2089x1764px:
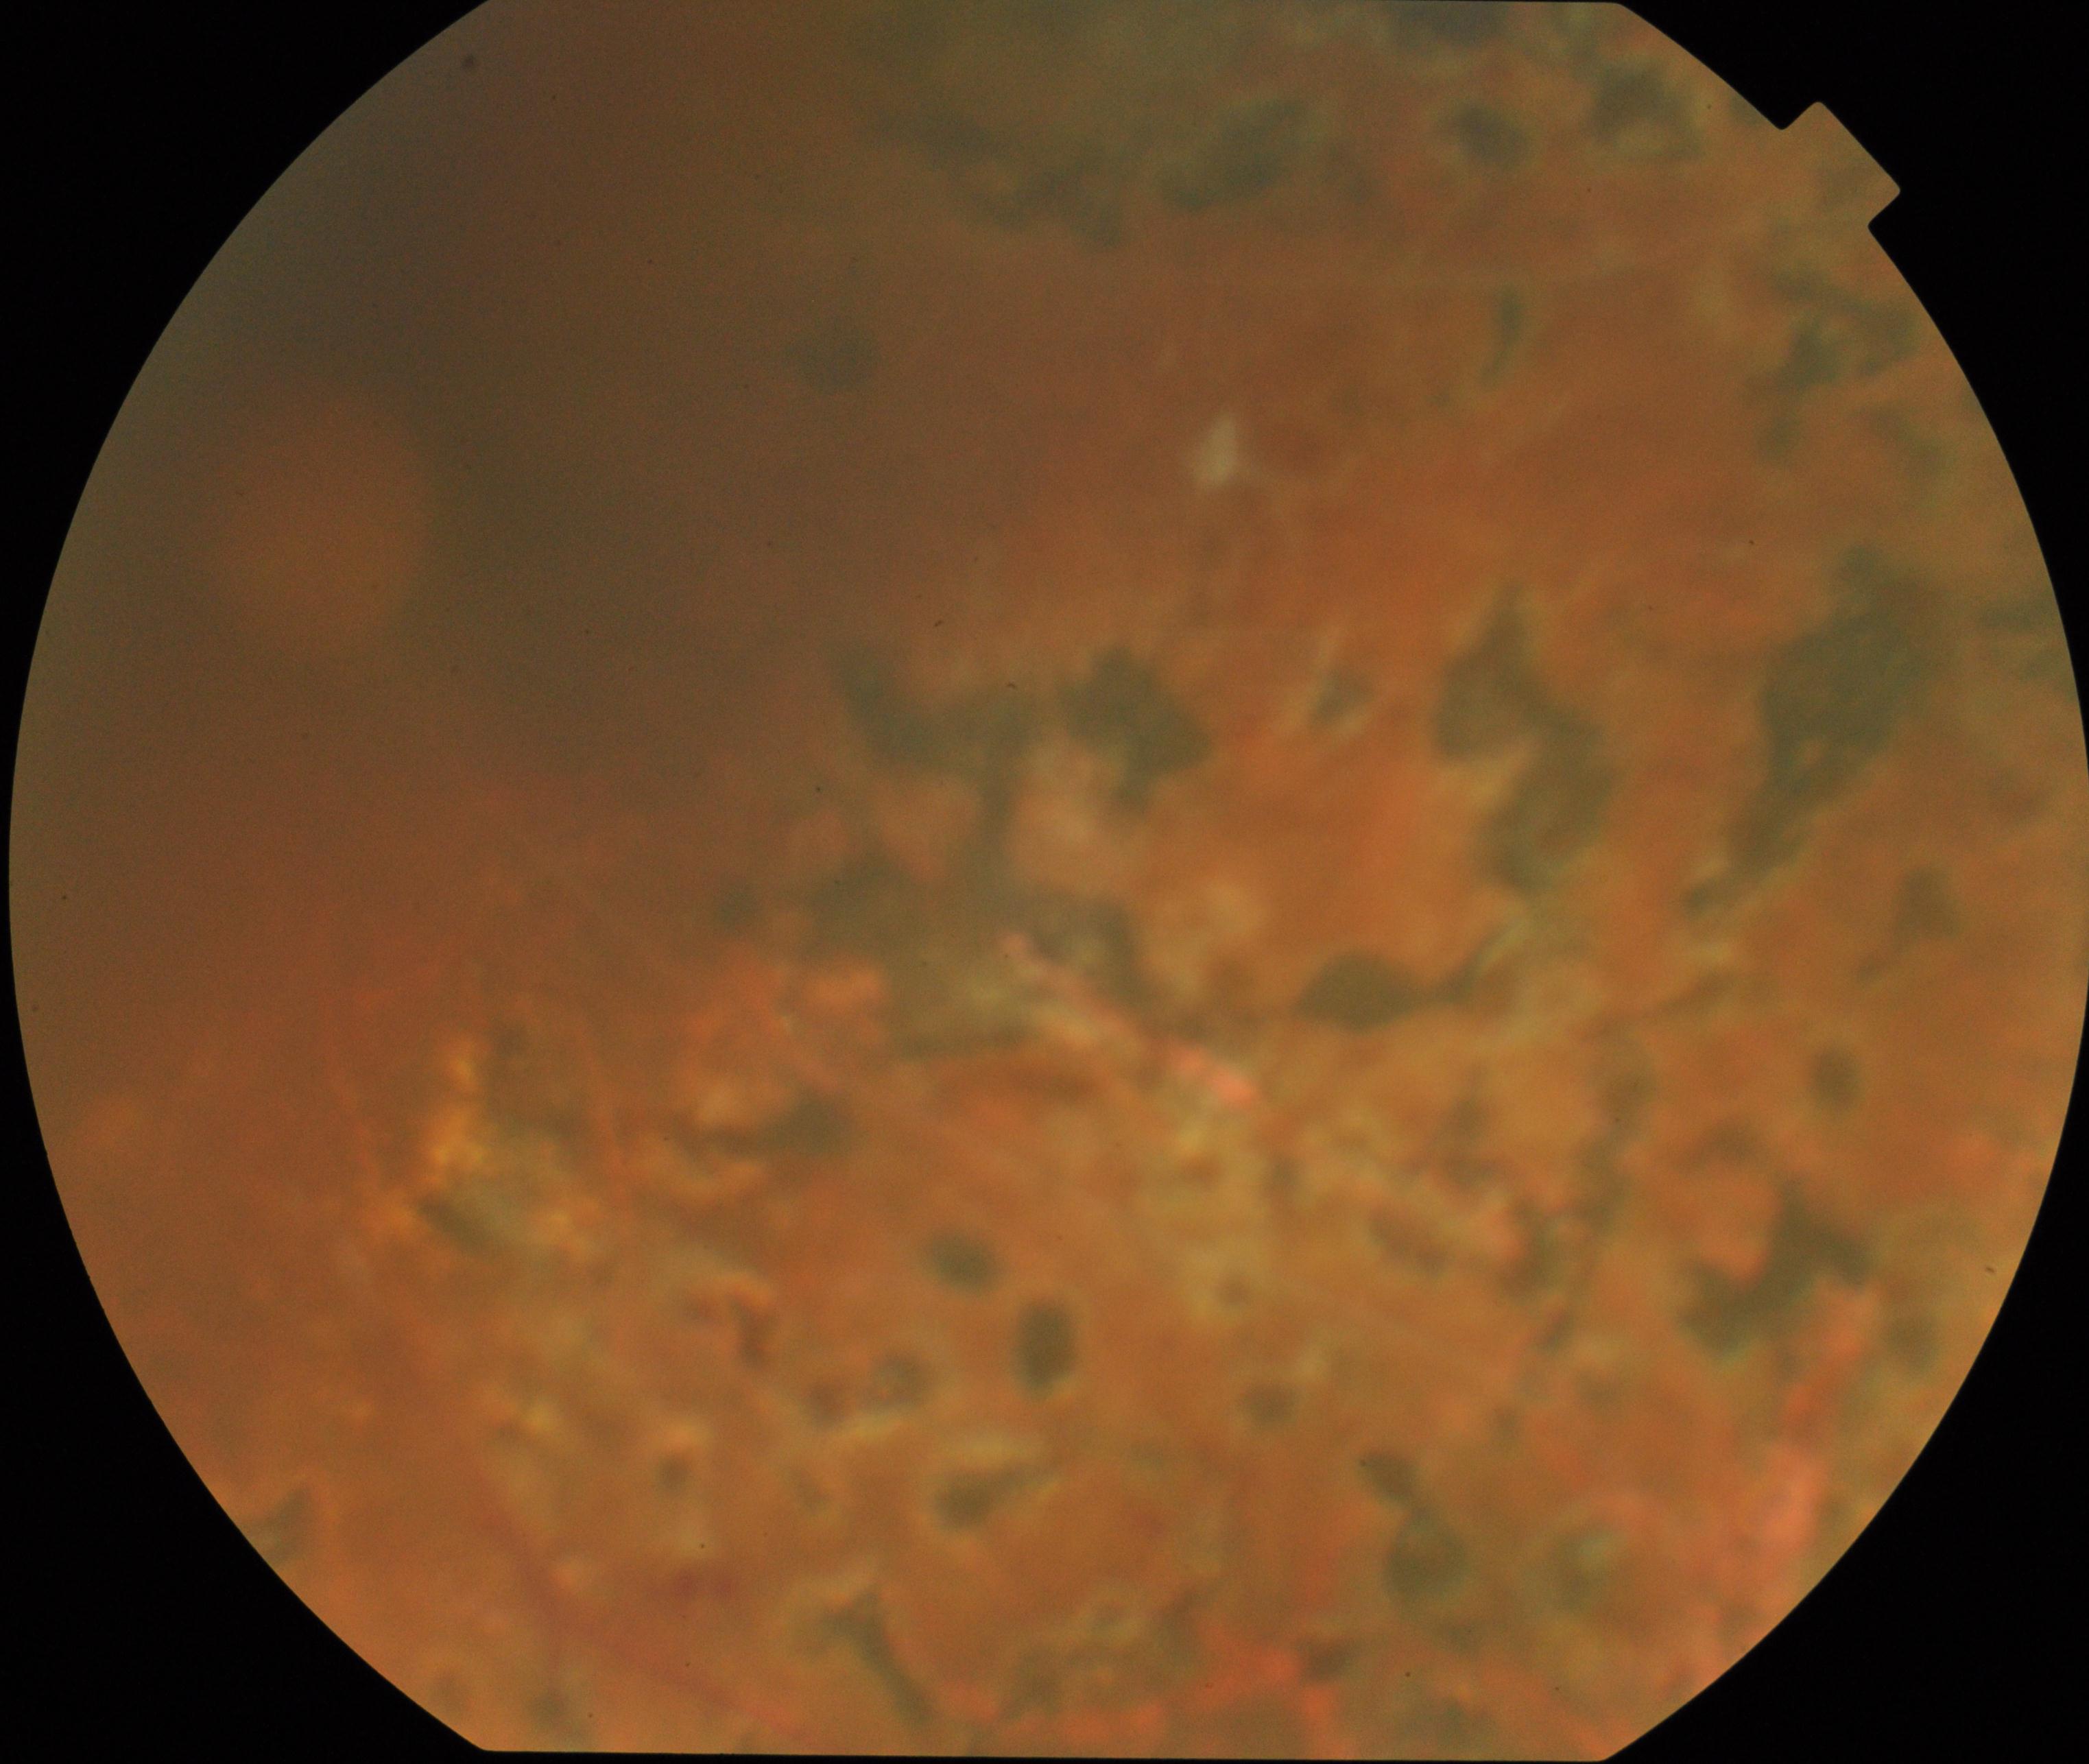

Impression: laser spots.